640x480 · RetCam wide-field infant fundus image: 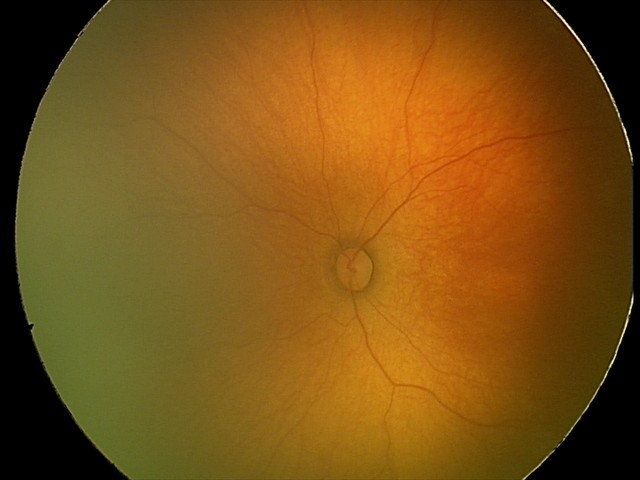

Plus disease = absent; ROP diagnosis = stage 1.